2352x1568px
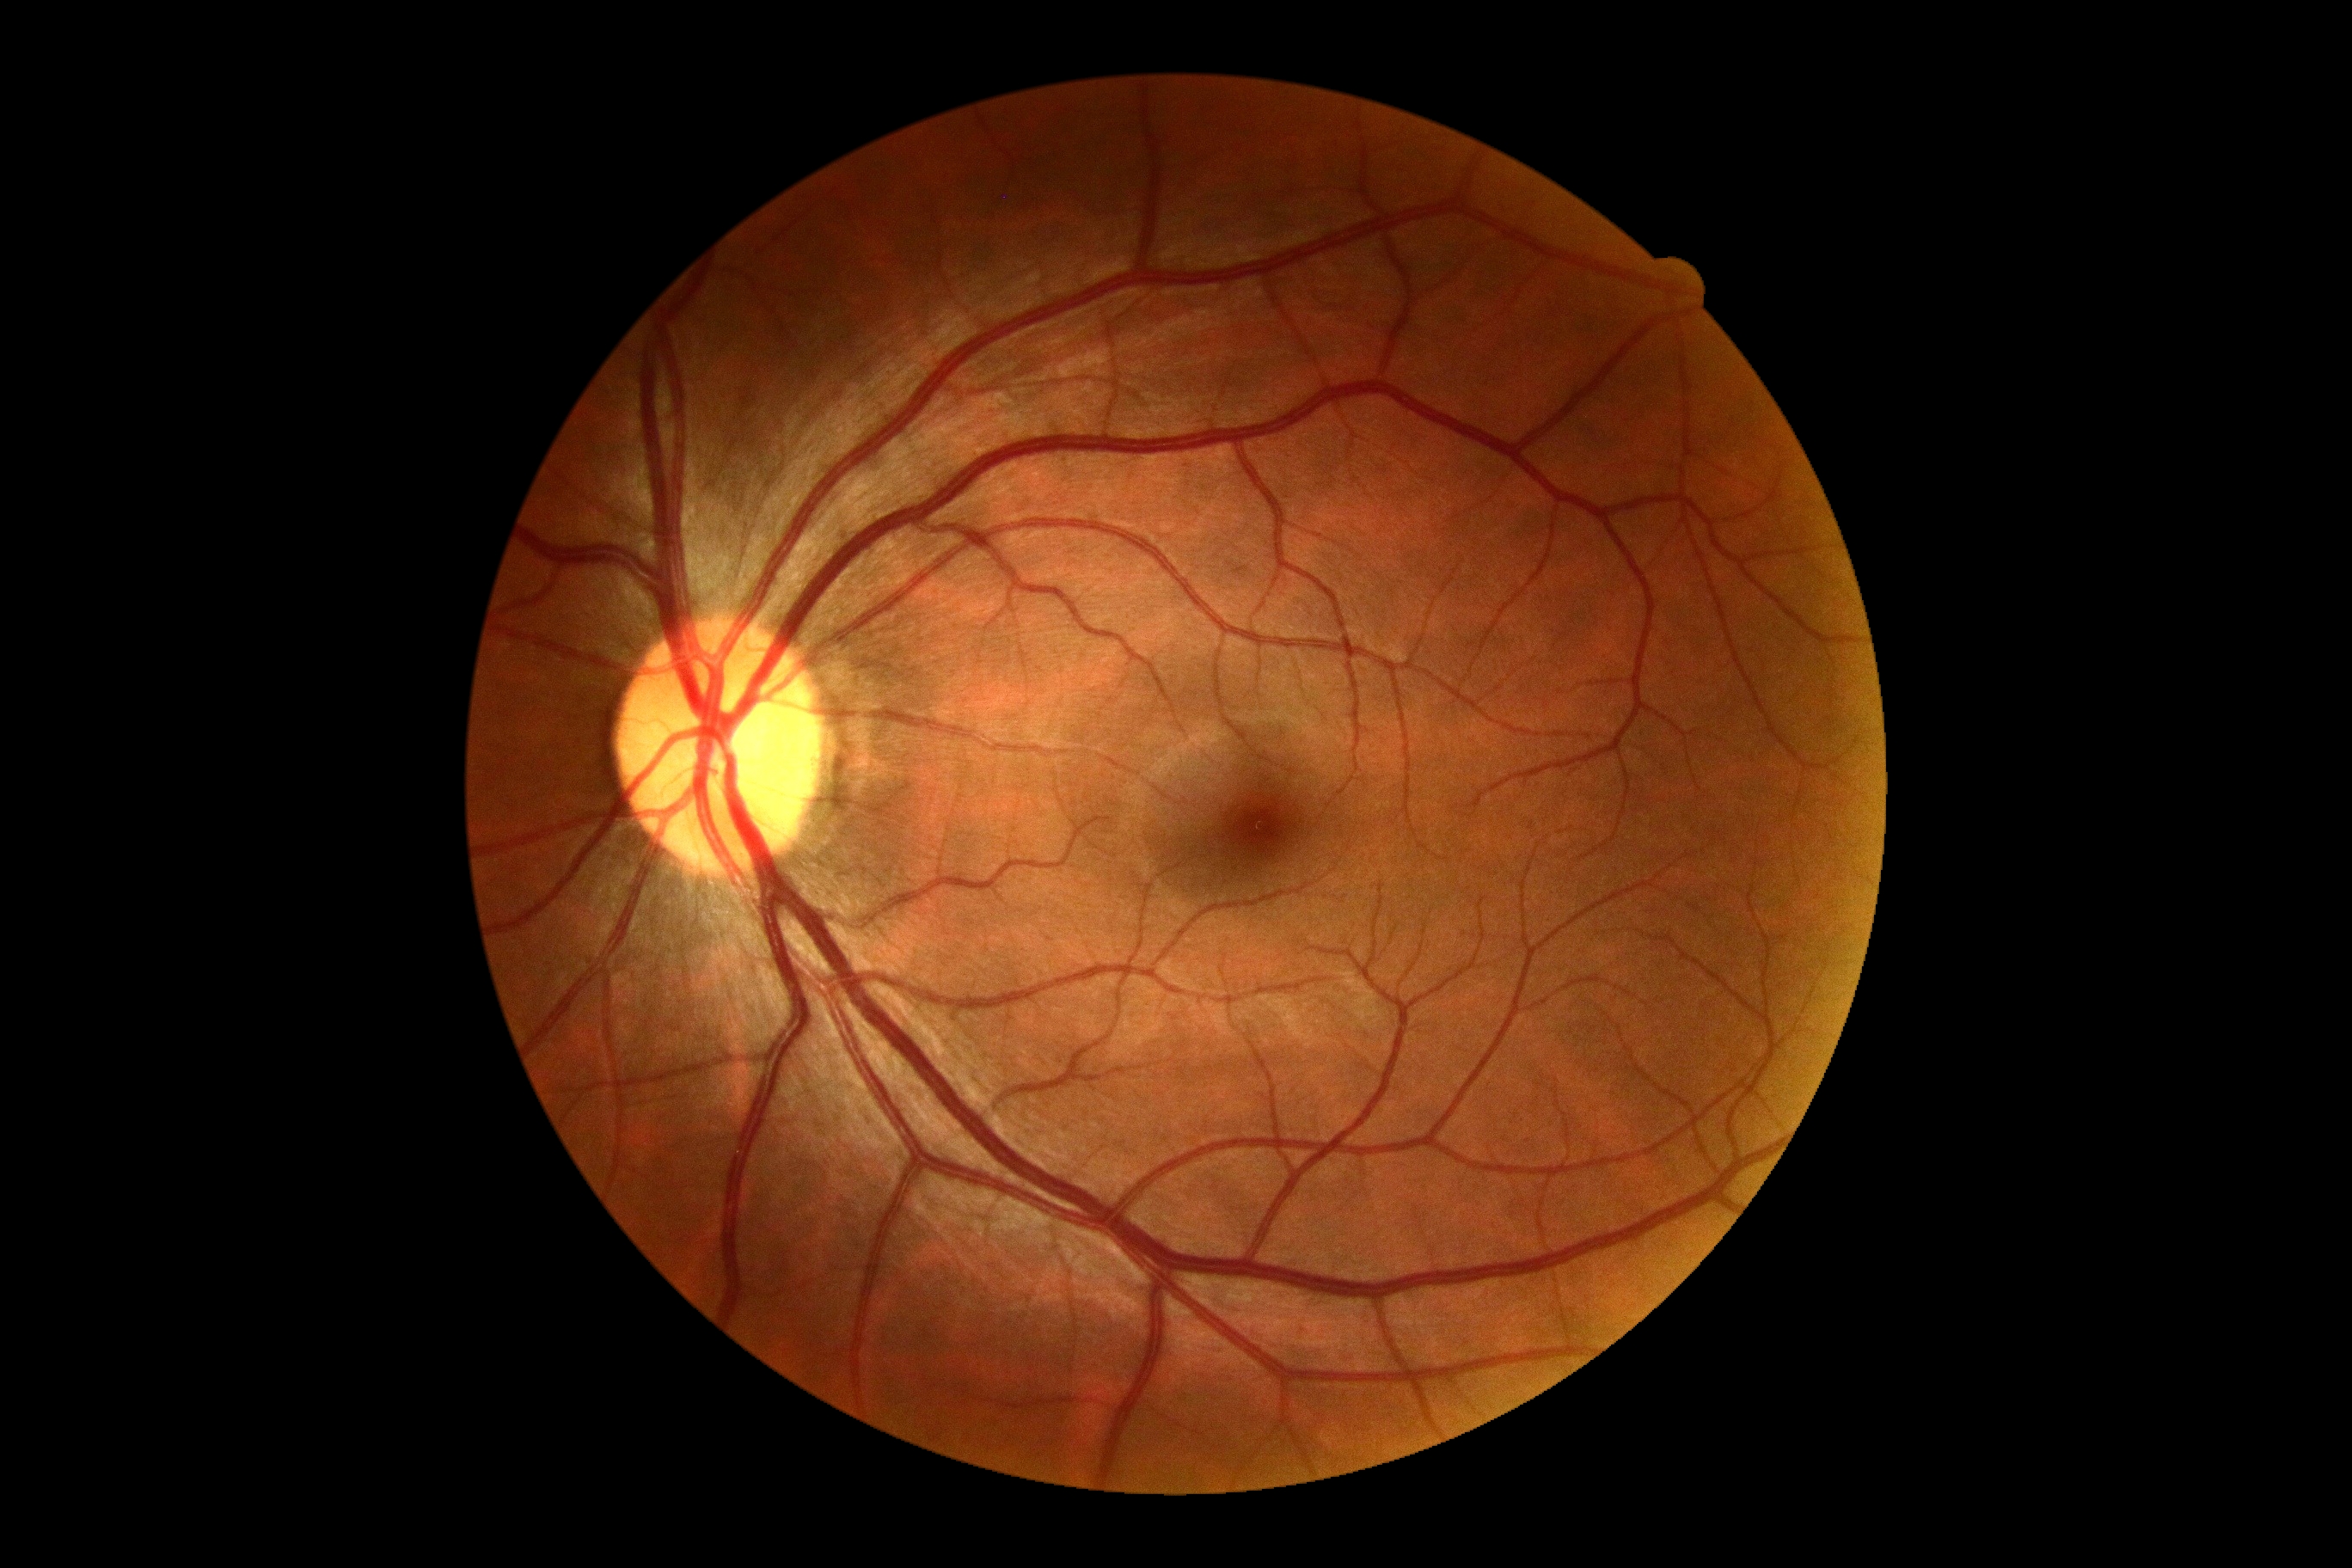
  dr_grade: grade 0 — no visible signs of diabetic retinopathy